45° field of view, acquired with a Canon CR-1
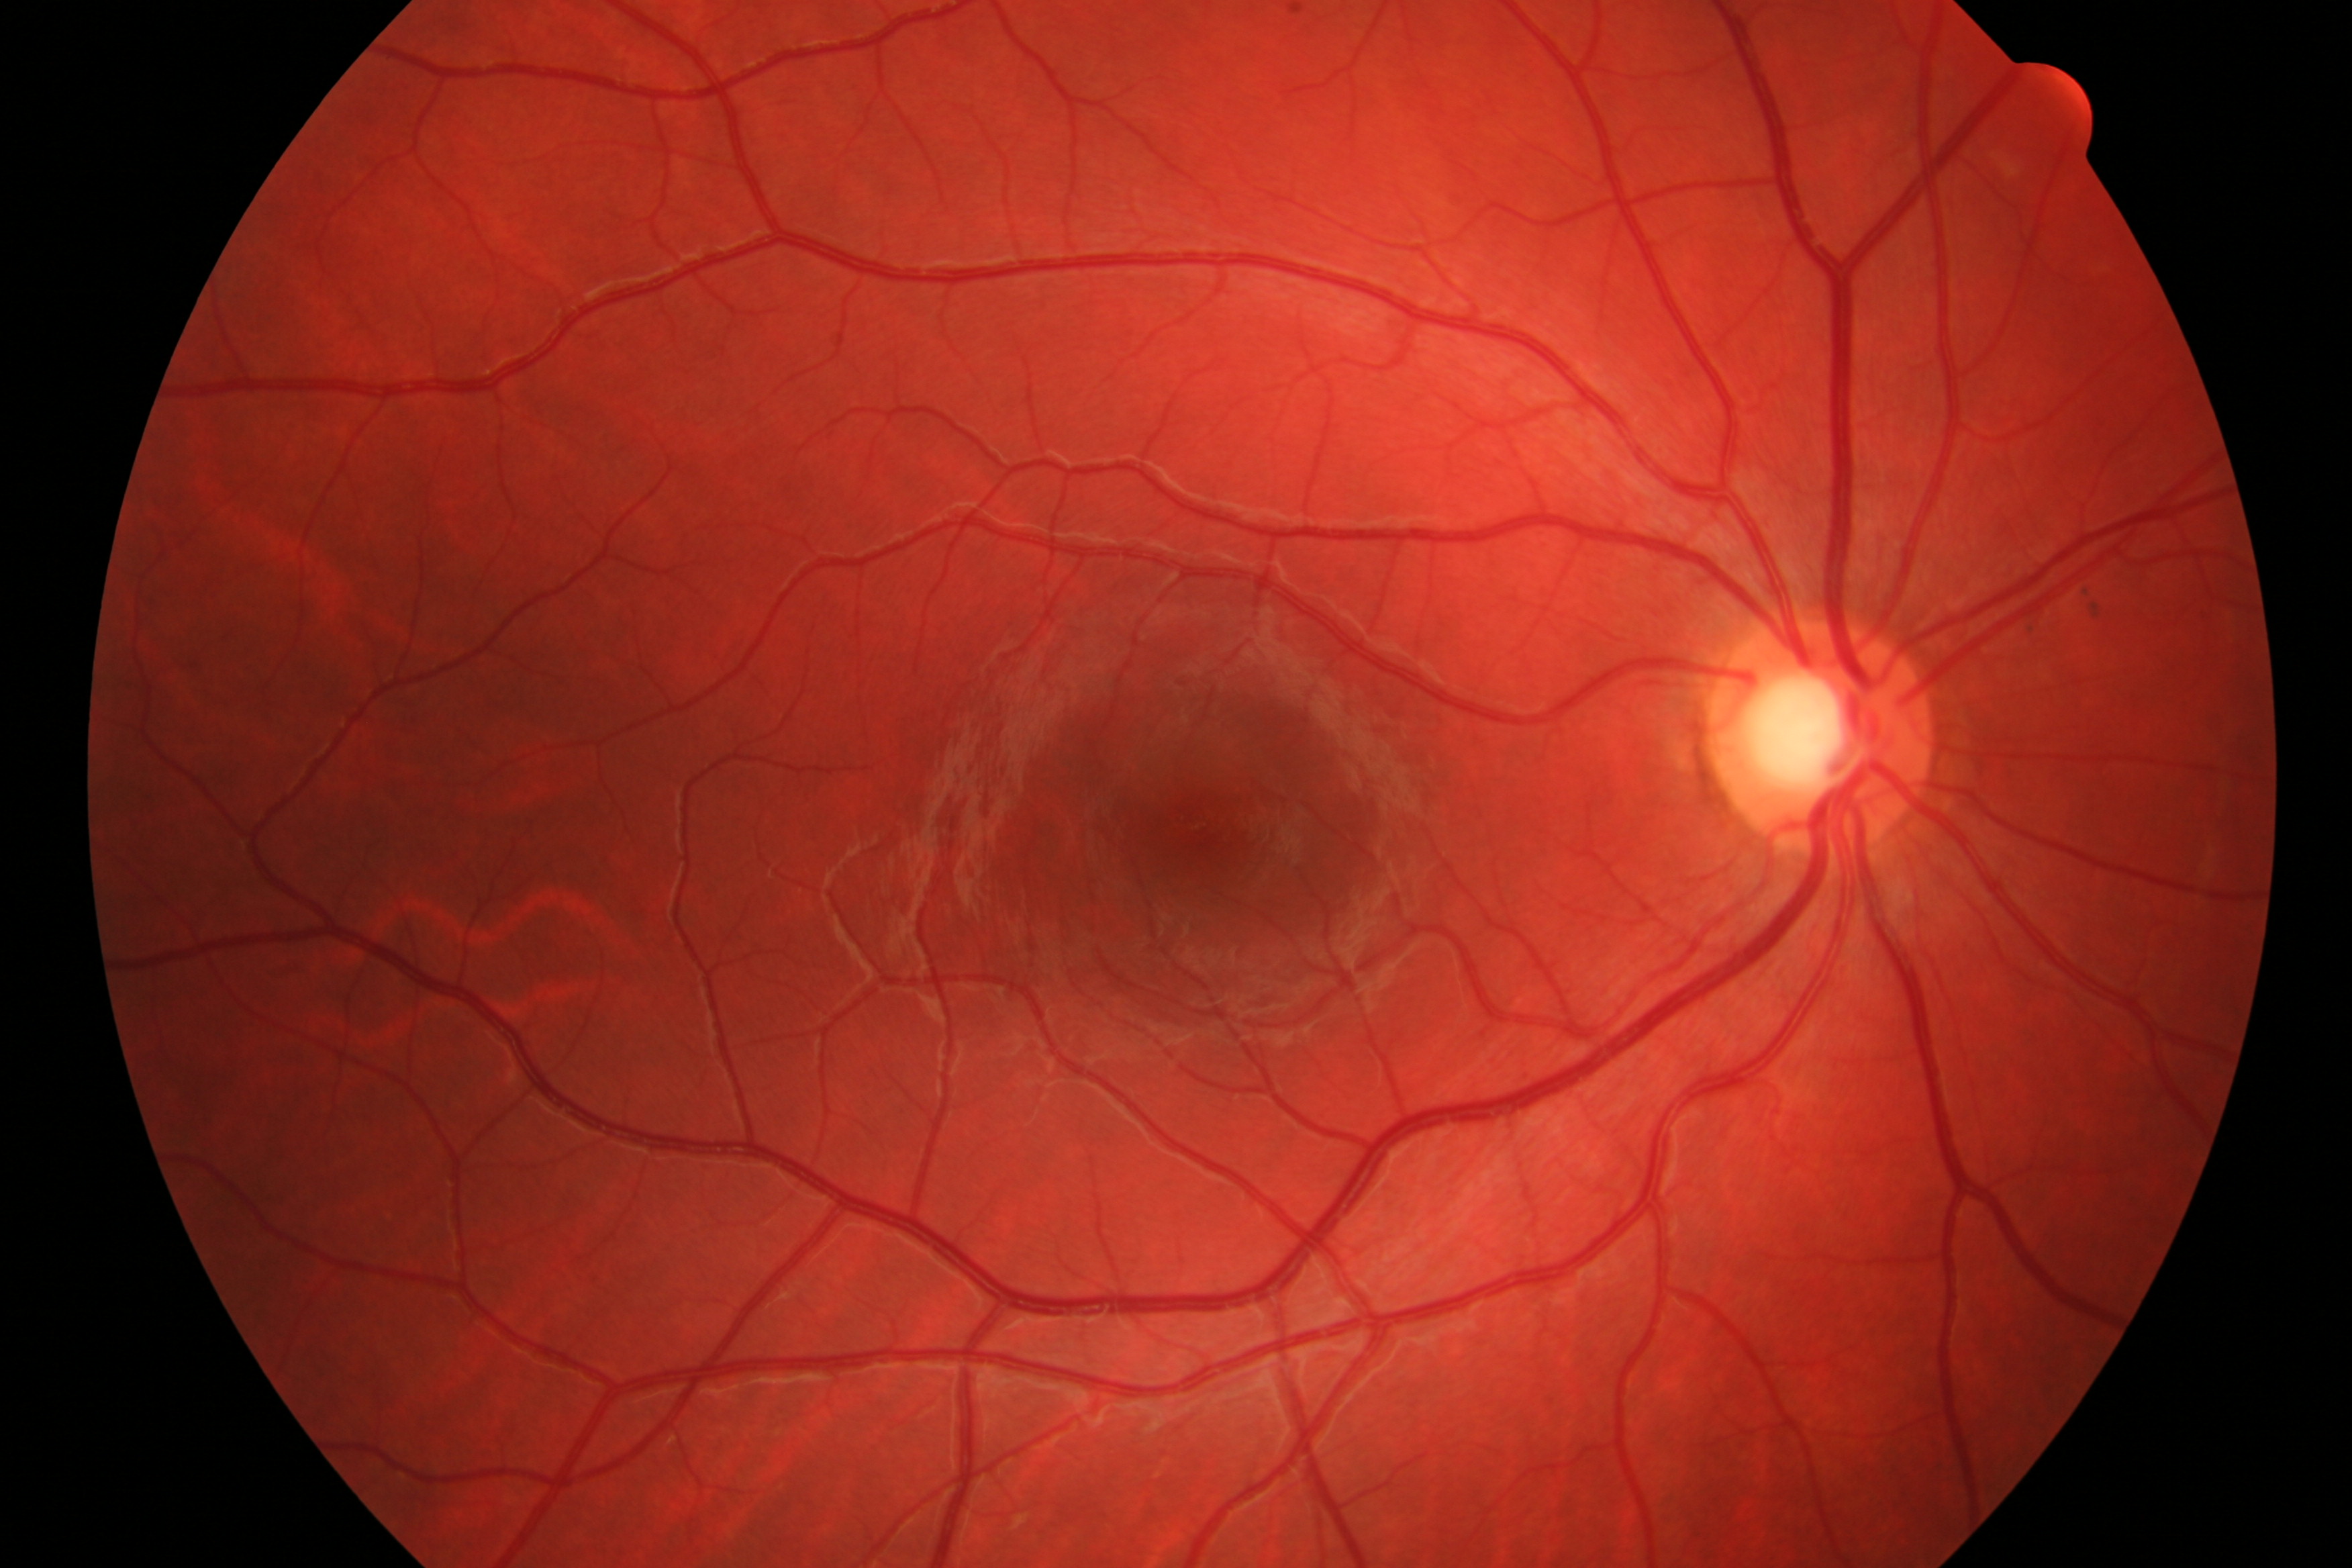

Findings: no evidence of DR or glaucoma.